Camera: Clarity RetCam 3 (130° FOV); infant wide-field fundus photograph — 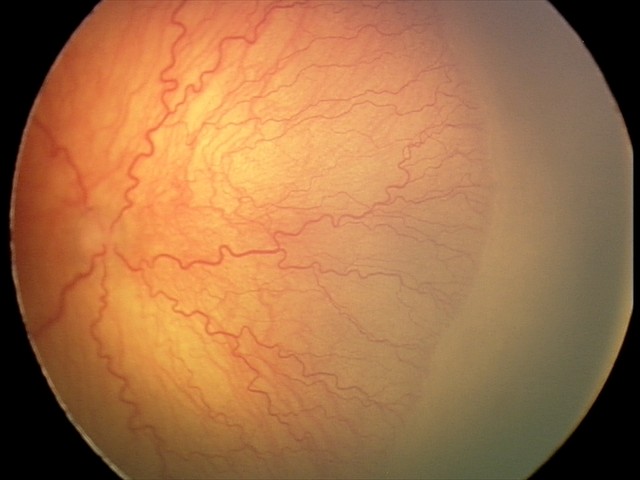
Assessment: plus disease | aggressive retinopathy of prematurity.